Fundus photo · nonmydriatic · NIDEK AFC-230: 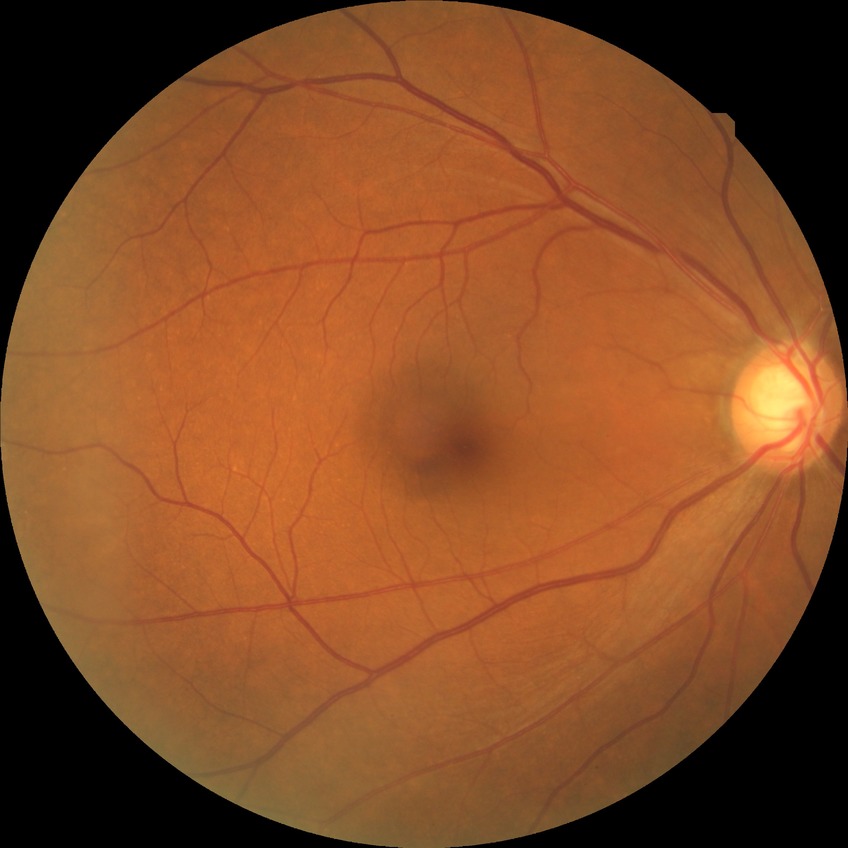
diabetic retinopathy (DR)=no diabetic retinopathy (NDR).